Without pupil dilation; camera: NIDEK AFC-230; color fundus photograph; 848x848px.
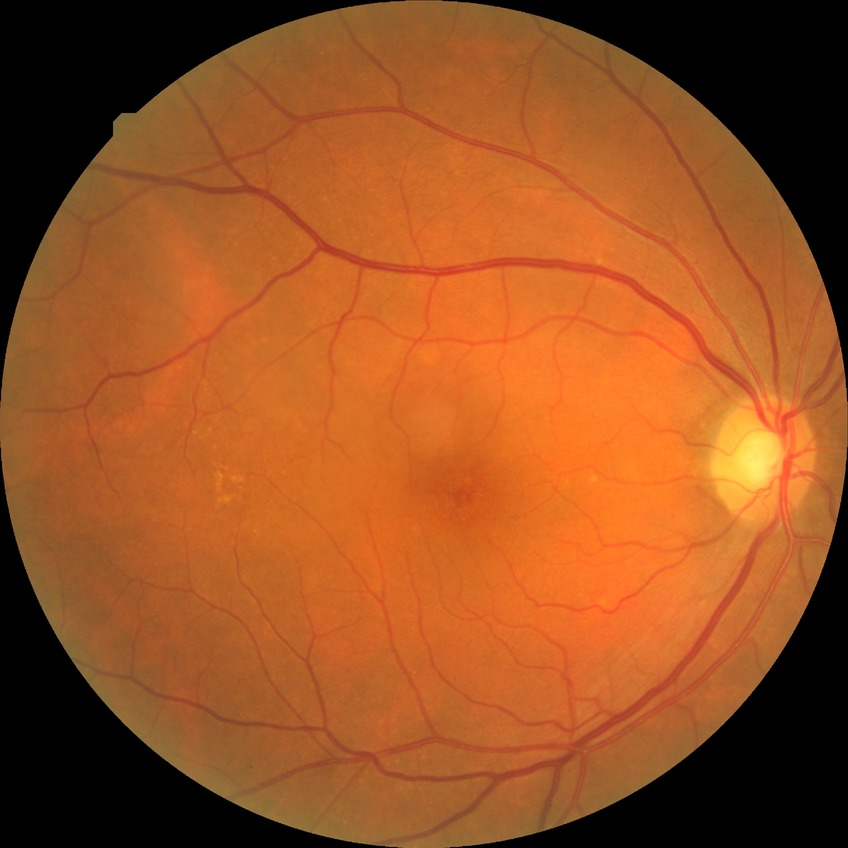
modified Davis grade: SDR.